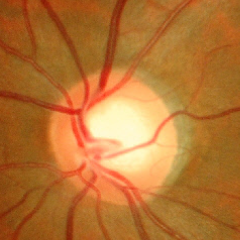
Fundus image with findings of no glaucomatous changes.